2352x1568px. 45-degree field of view: 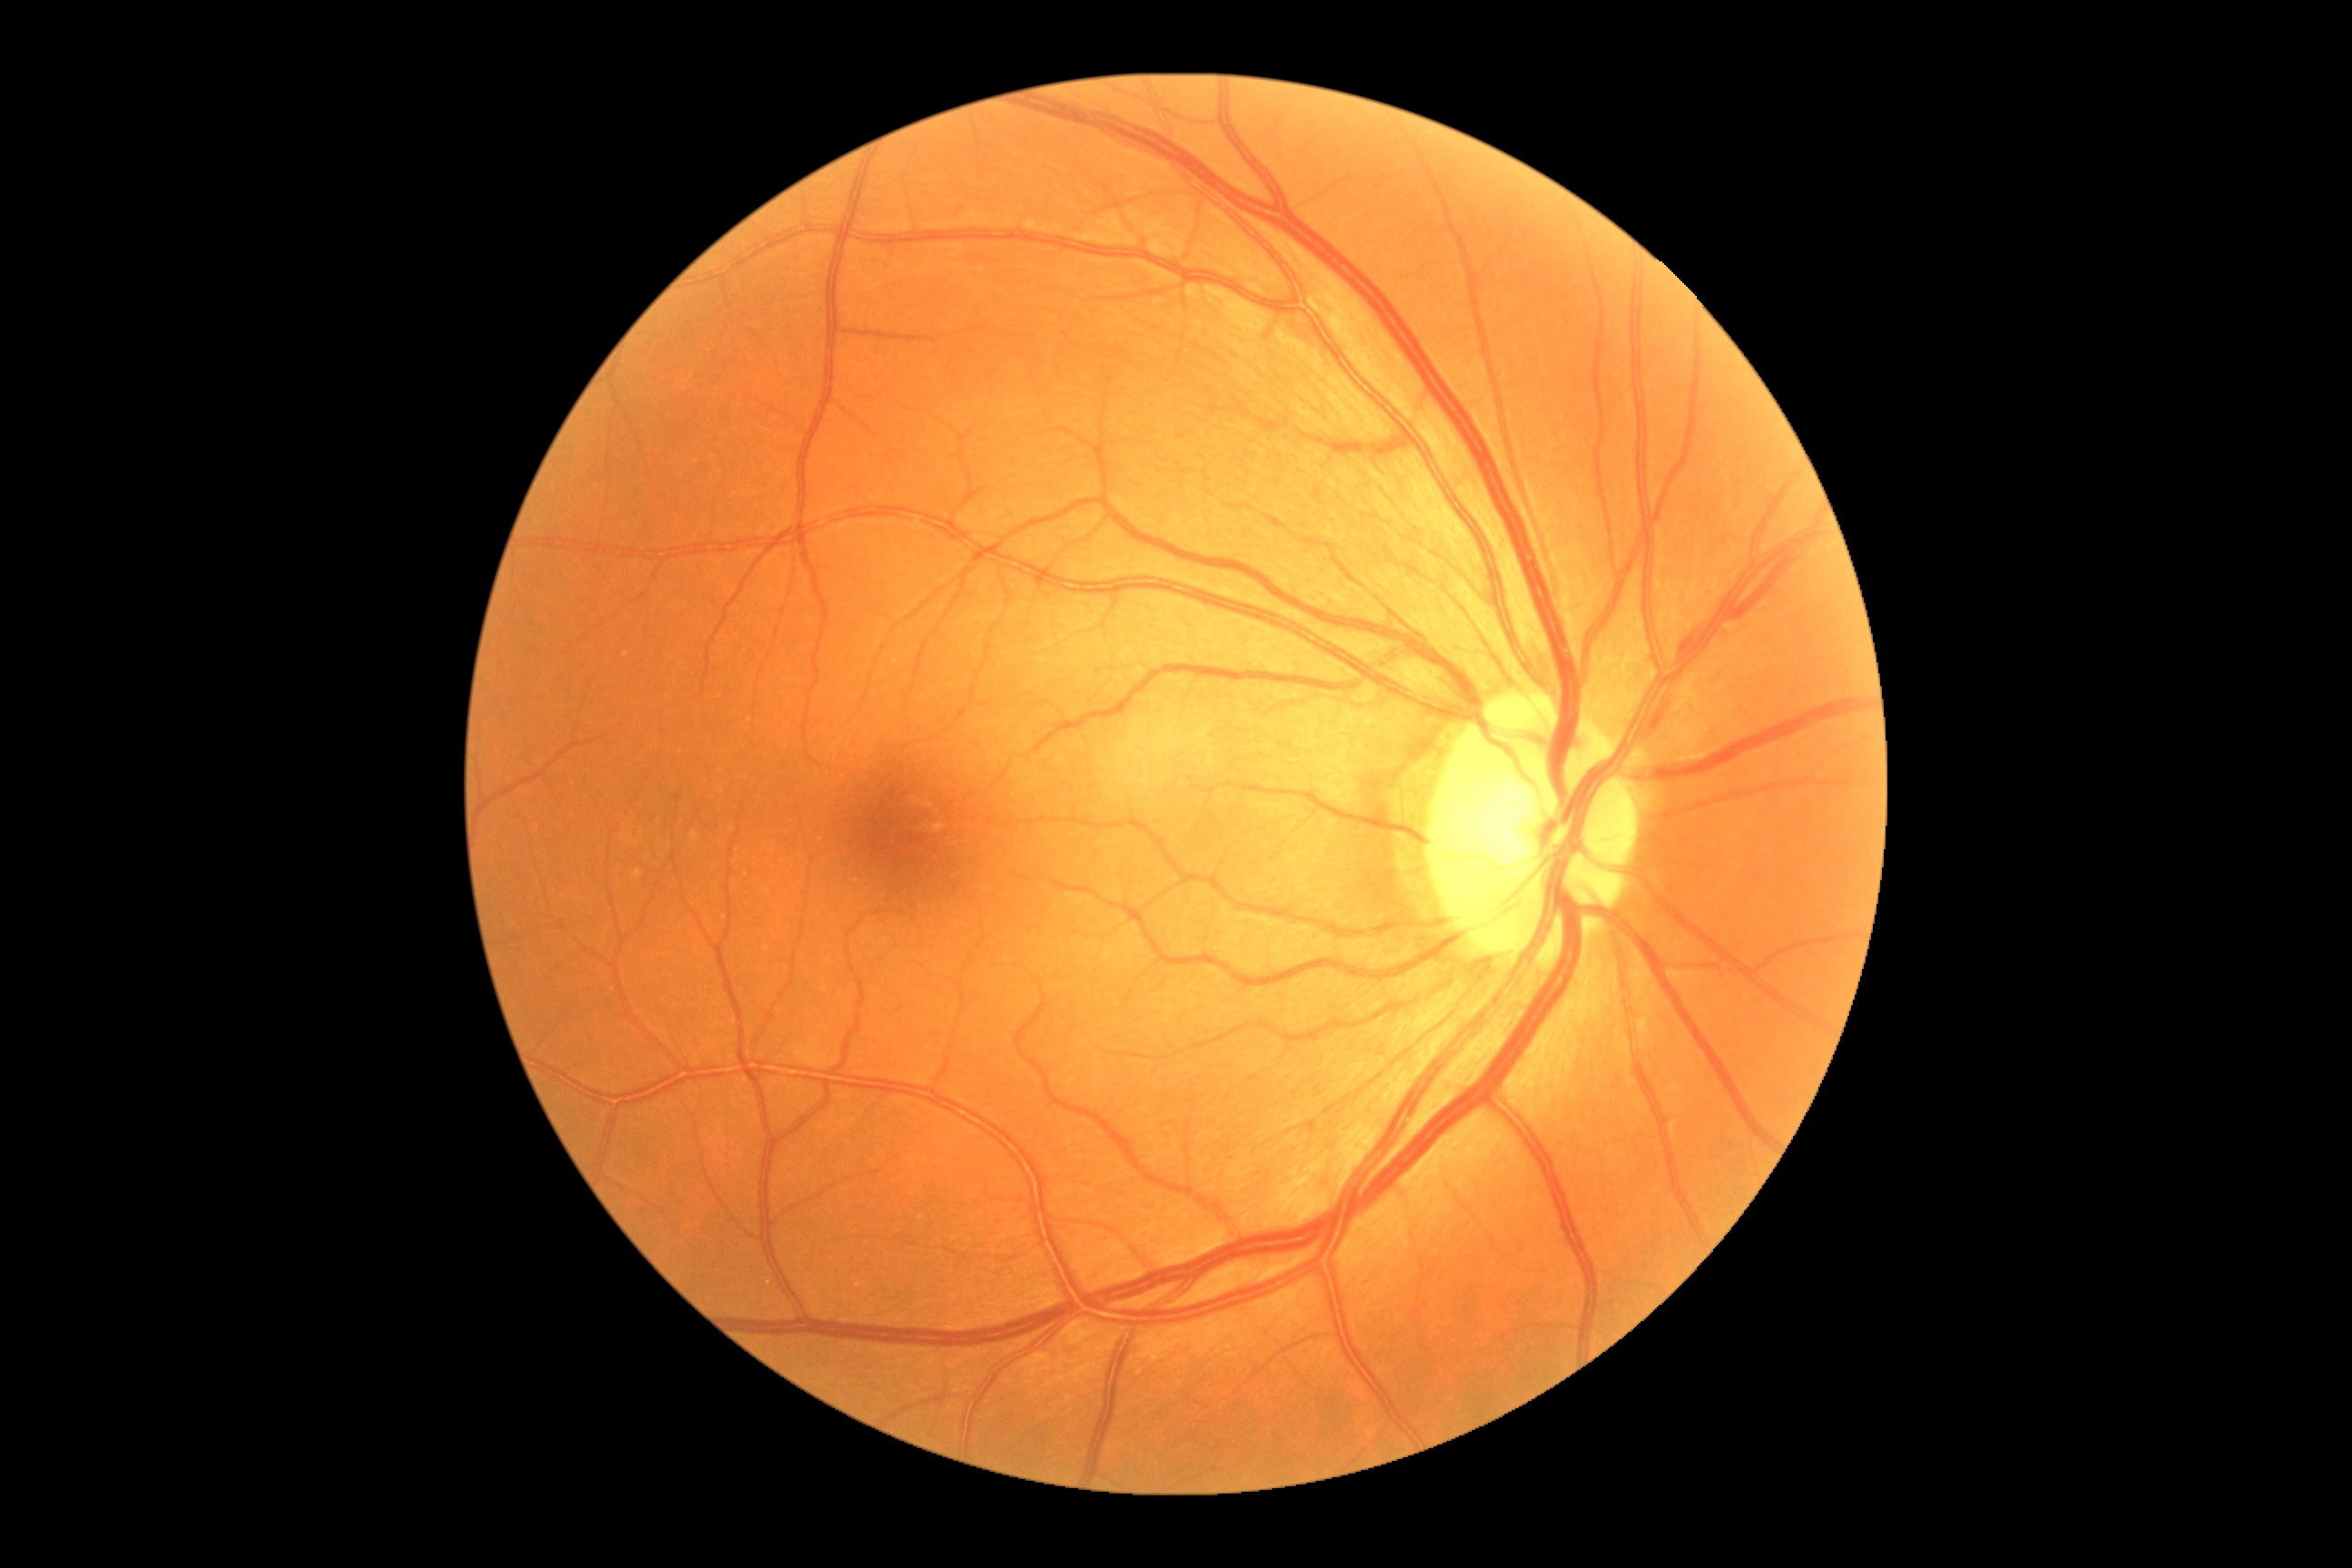
Retinopathy grade is 0 (no apparent retinopathy).